45° FOV · without pupil dilation · 848x848 · camera: NIDEK AFC-230:
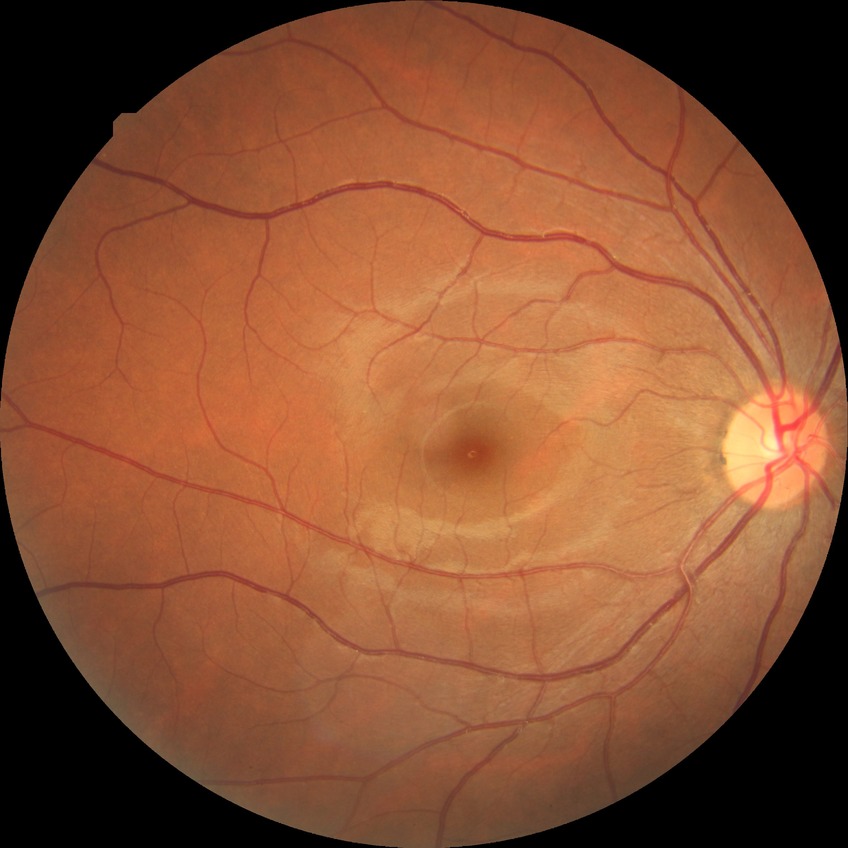
- Davis grading: no diabetic retinopathy